Without pupil dilation. CFP.
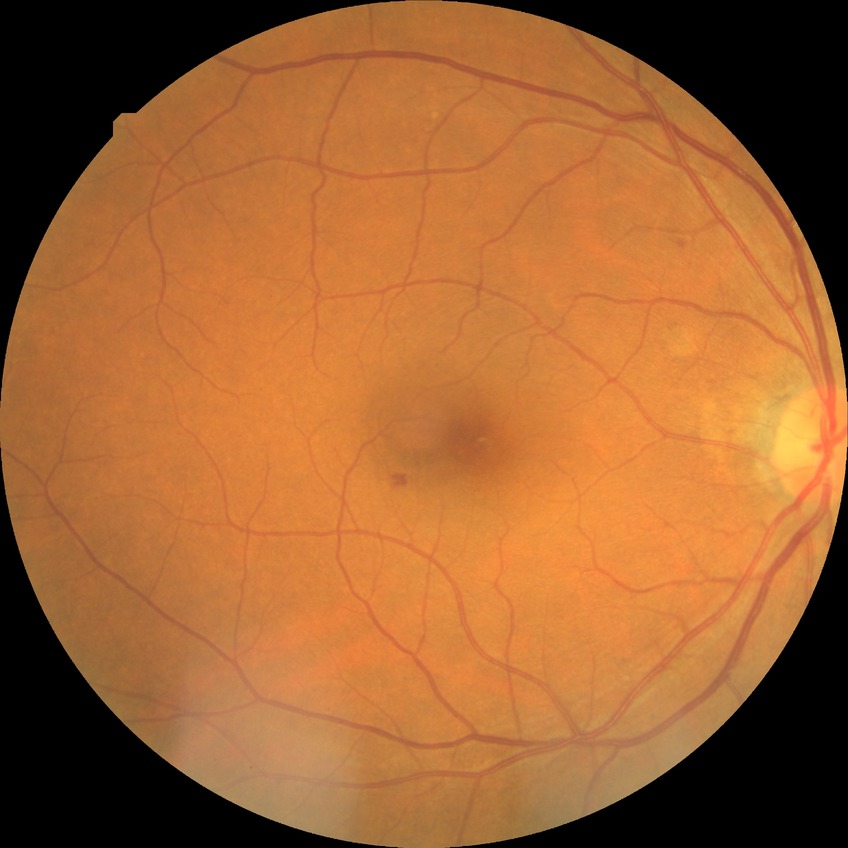 diabetic retinopathy stage = simple diabetic retinopathy, DR class = non-proliferative diabetic retinopathy.